CFP, 45-degree field of view, image size 2352x1568 — 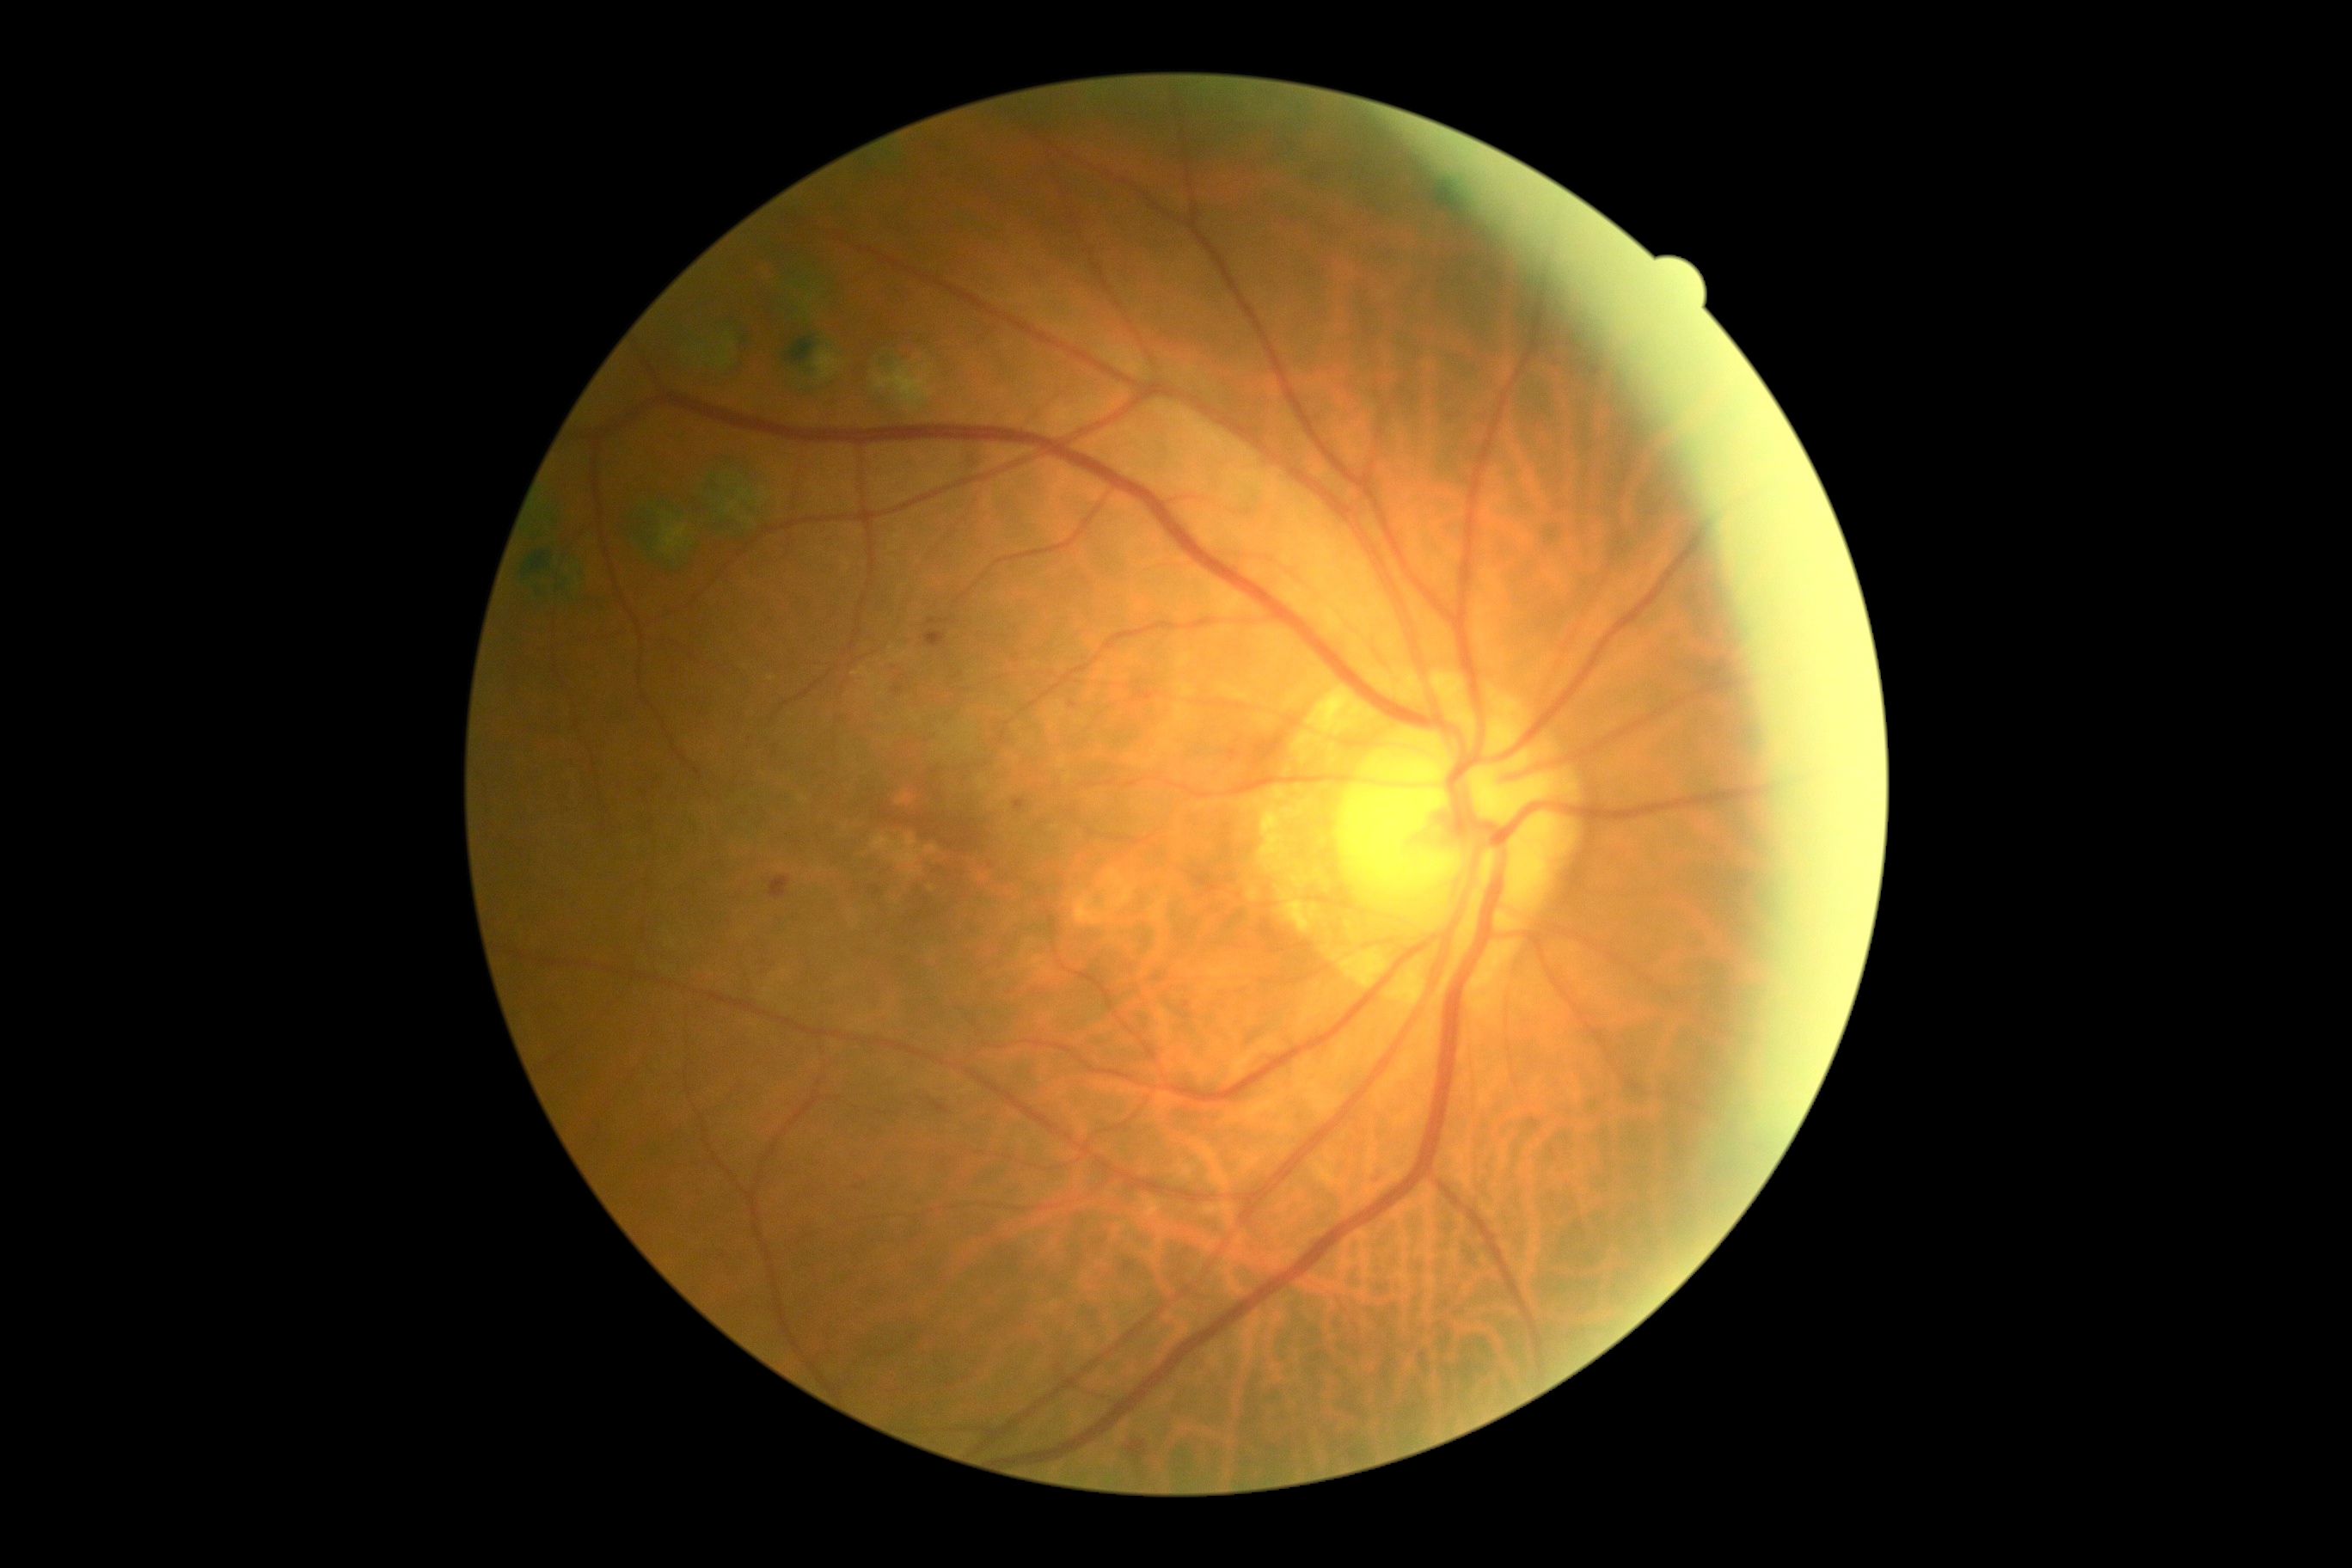 * retinopathy — grade 2 (moderate NPDR)